Color fundus image; 2352x1568px: 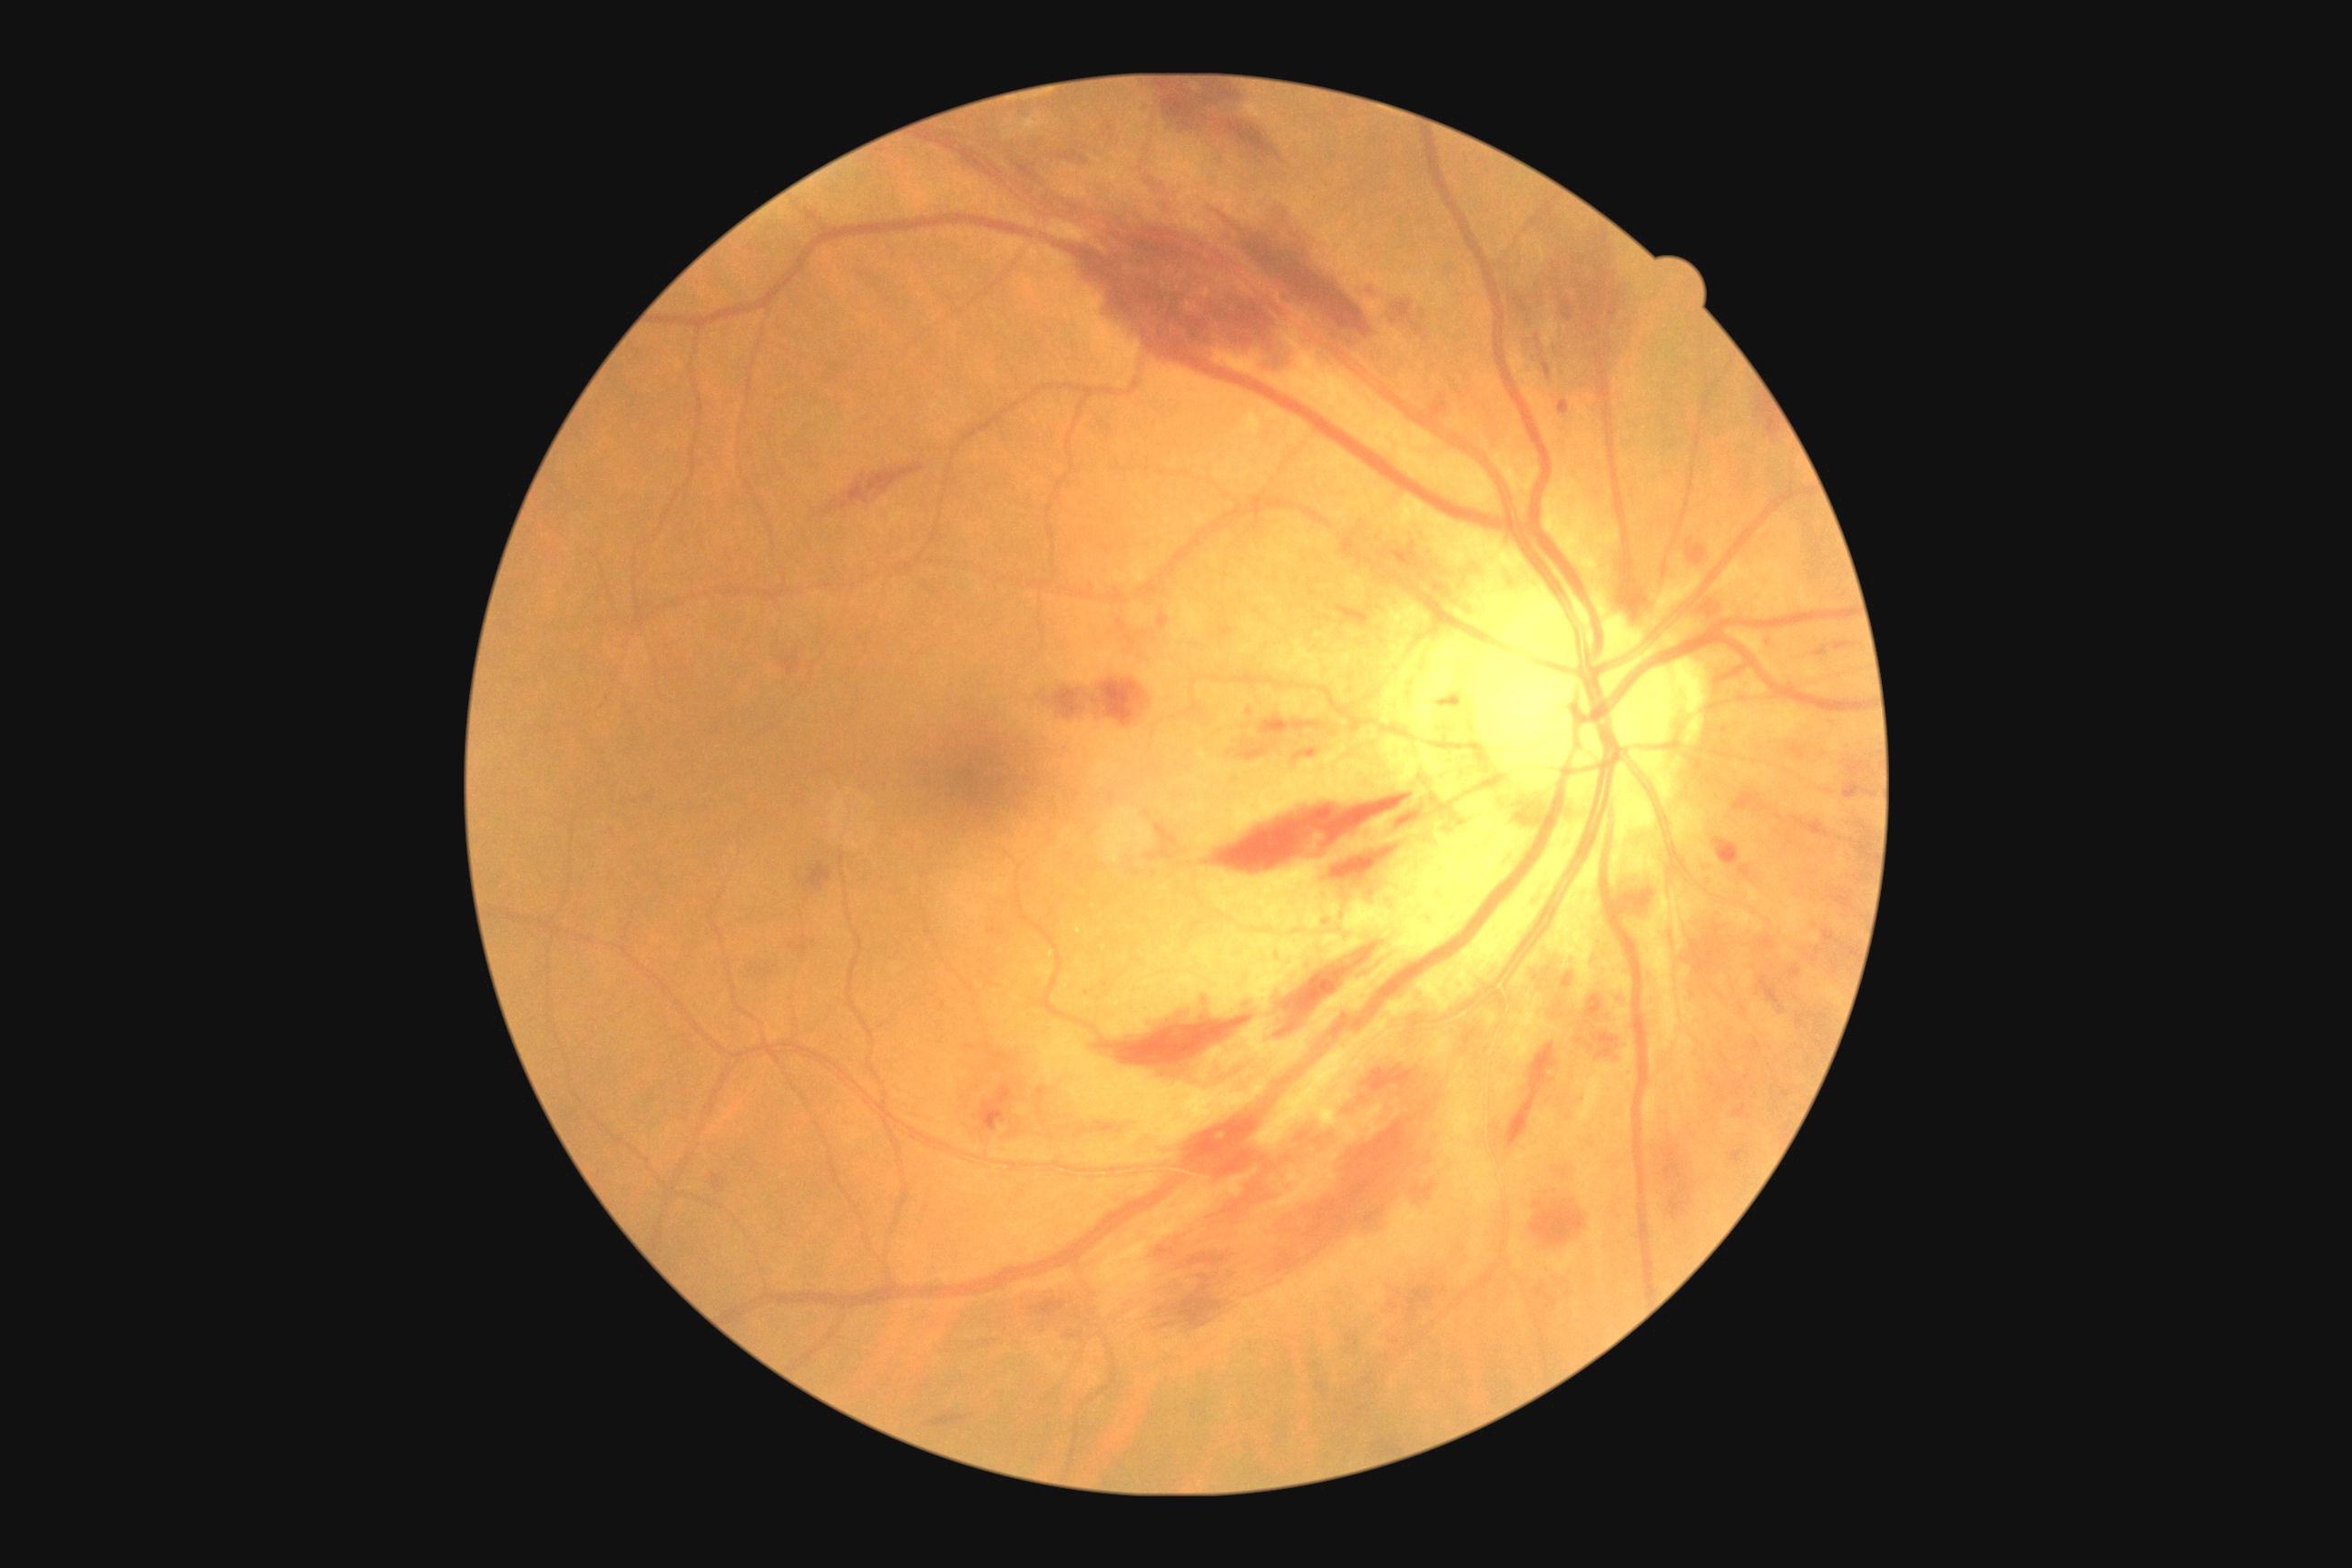 Diabetic retinopathy grade is moderate non-proliferative diabetic retinopathy (2)
Representative lesions:
hemorrhages (subset): (left=1275, top=943, right=1391, bottom=1039) | (left=1830, top=890, right=1857, bottom=912) | (left=1563, top=293, right=1569, bottom=322) | (left=1587, top=1044, right=1594, bottom=1052) | (left=1756, top=402, right=1778, bottom=436) | (left=979, top=1084, right=1014, bottom=1132) | (left=1845, top=760, right=1870, bottom=778) | (left=1556, top=1168, right=1573, bottom=1182) | (left=1141, top=168, right=1181, bottom=195) | (left=1712, top=663, right=1752, bottom=685) | (left=783, top=651, right=799, bottom=672) | (left=1389, top=545, right=1404, bottom=564) | (left=1092, top=678, right=1152, bottom=727) | (left=1208, top=208, right=1380, bottom=342) | (left=925, top=1415, right=965, bottom=1427) | (left=1596, top=1046, right=1612, bottom=1059) | (left=1763, top=636, right=1772, bottom=649)